Fundus photo: 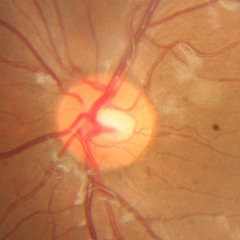 Showing no glaucomatous optic neuropathy.